Optic nerve head photograph
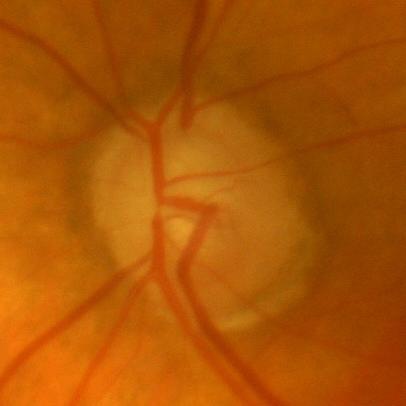
Q: Glaucoma assessment?
A: No — no glaucomatous changes.